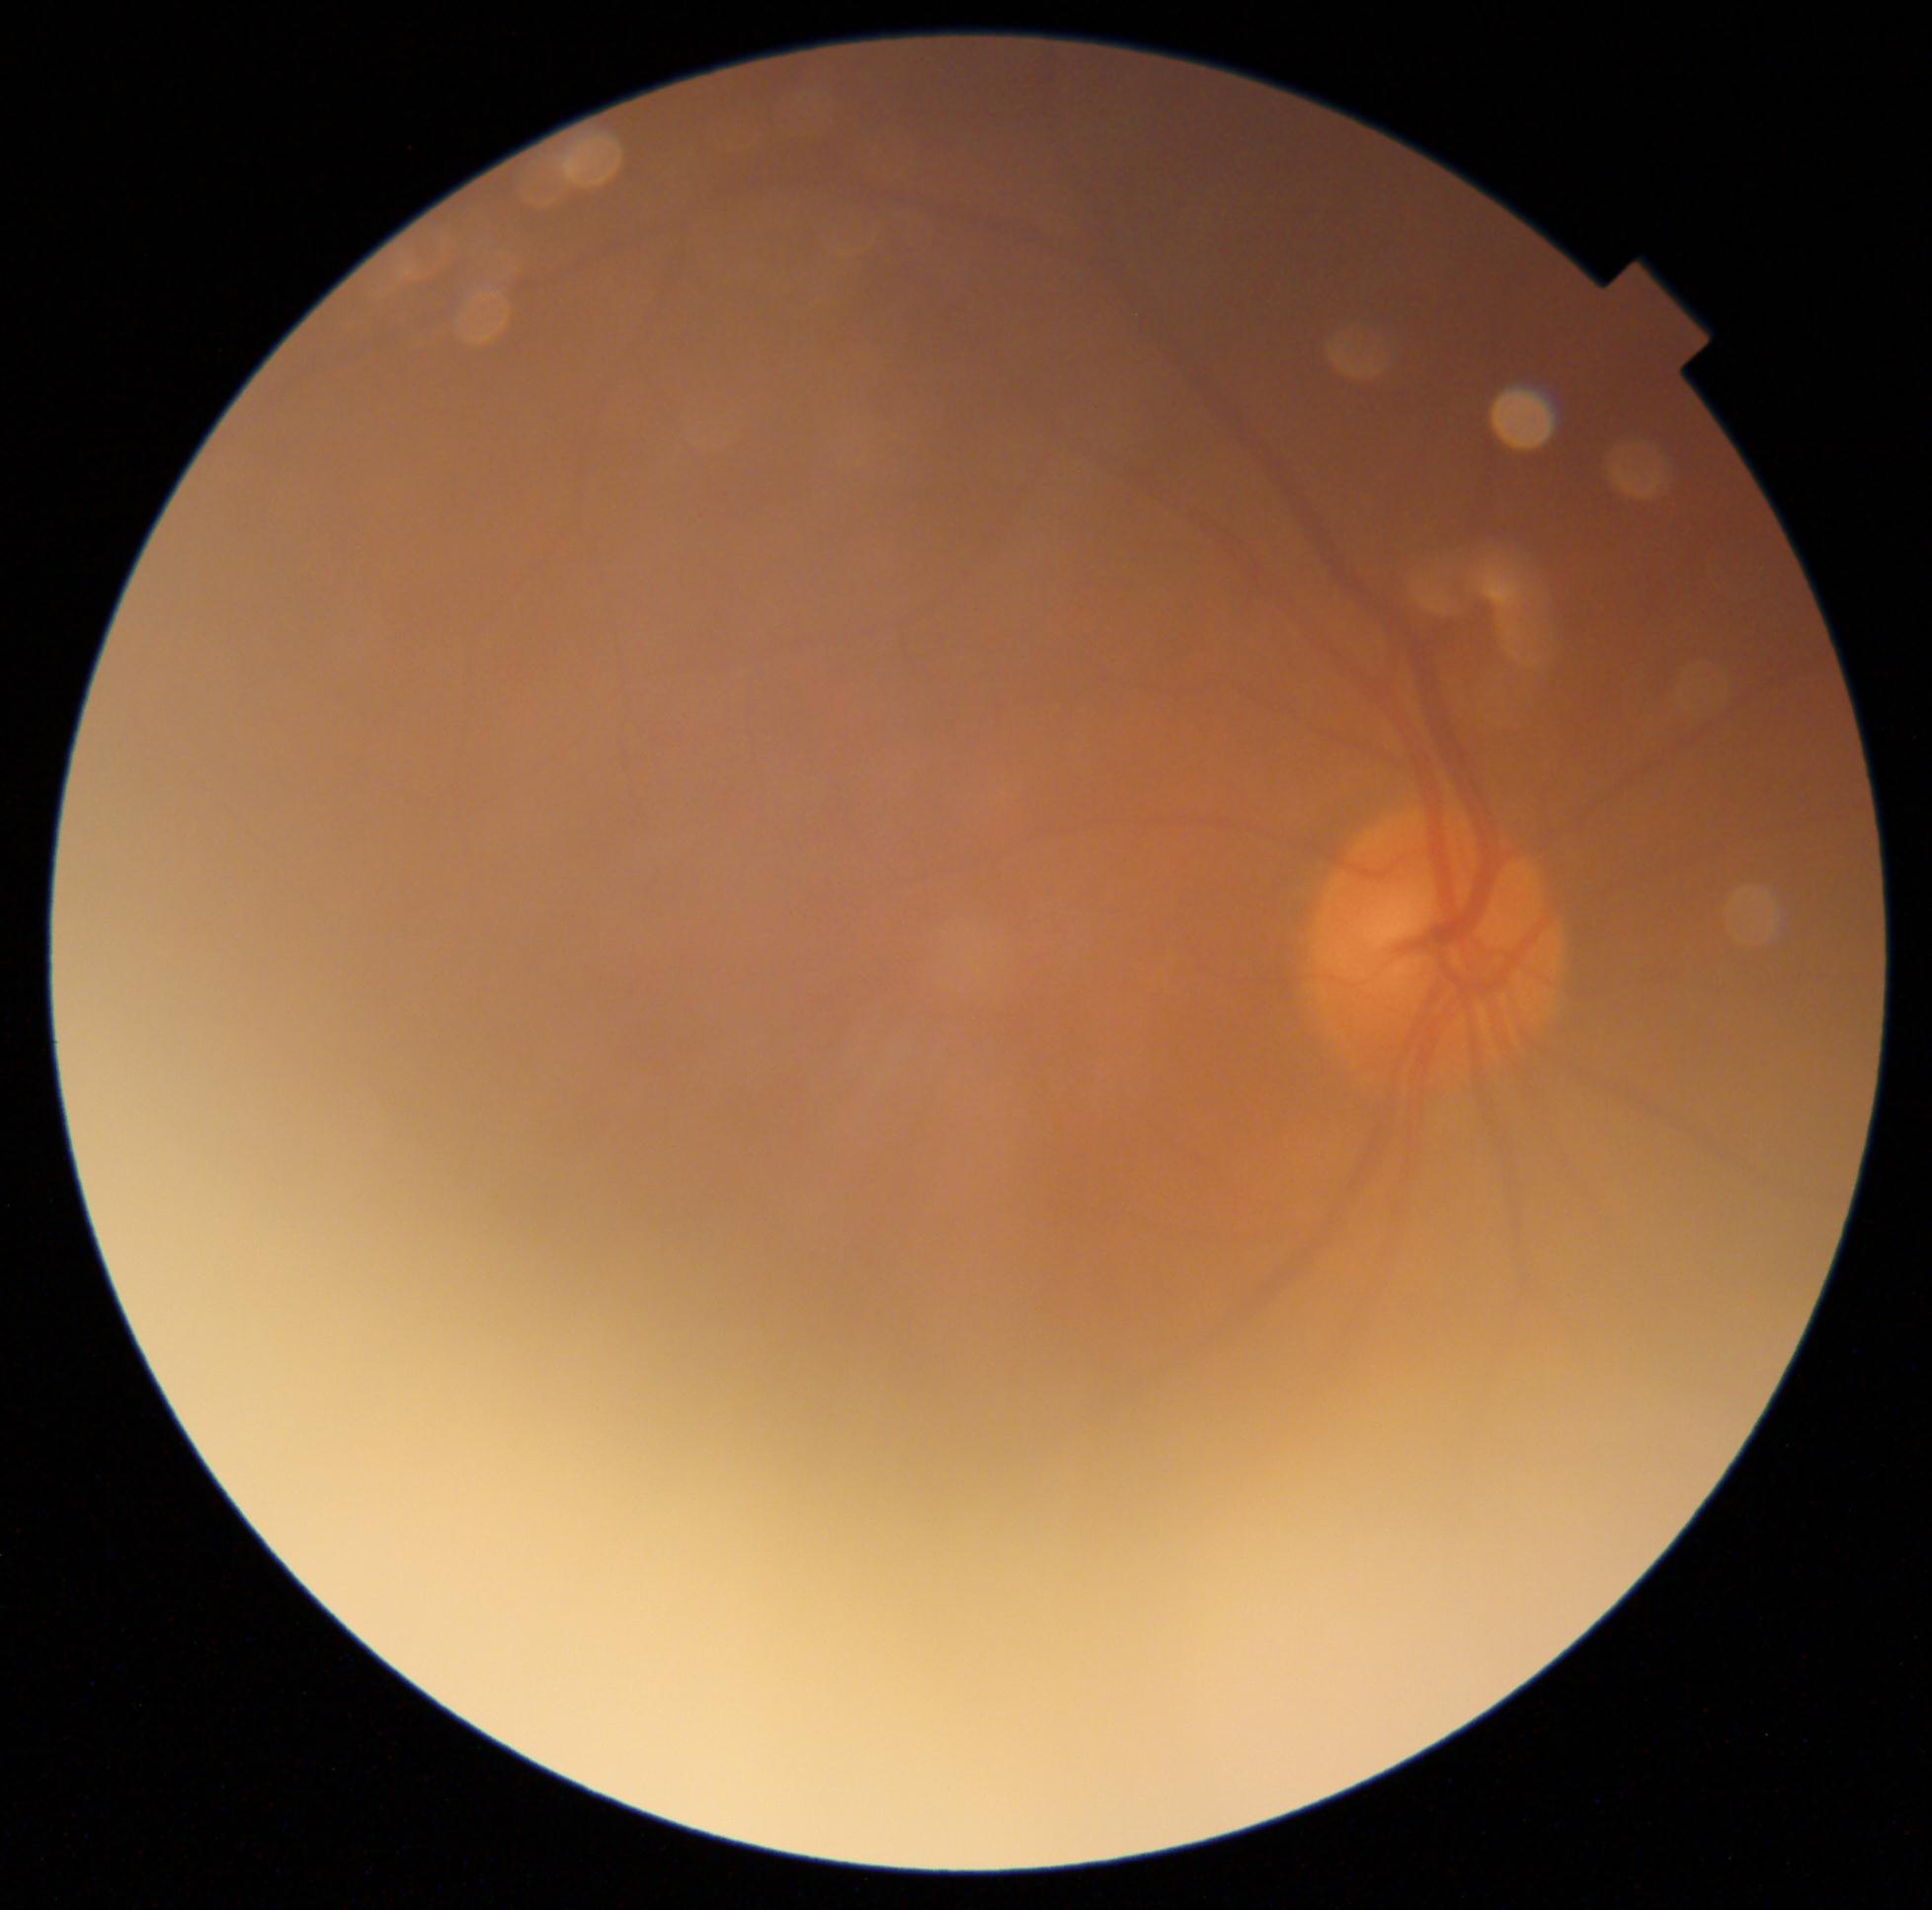

DR is no apparent retinopathy (grade 0).